CFP: 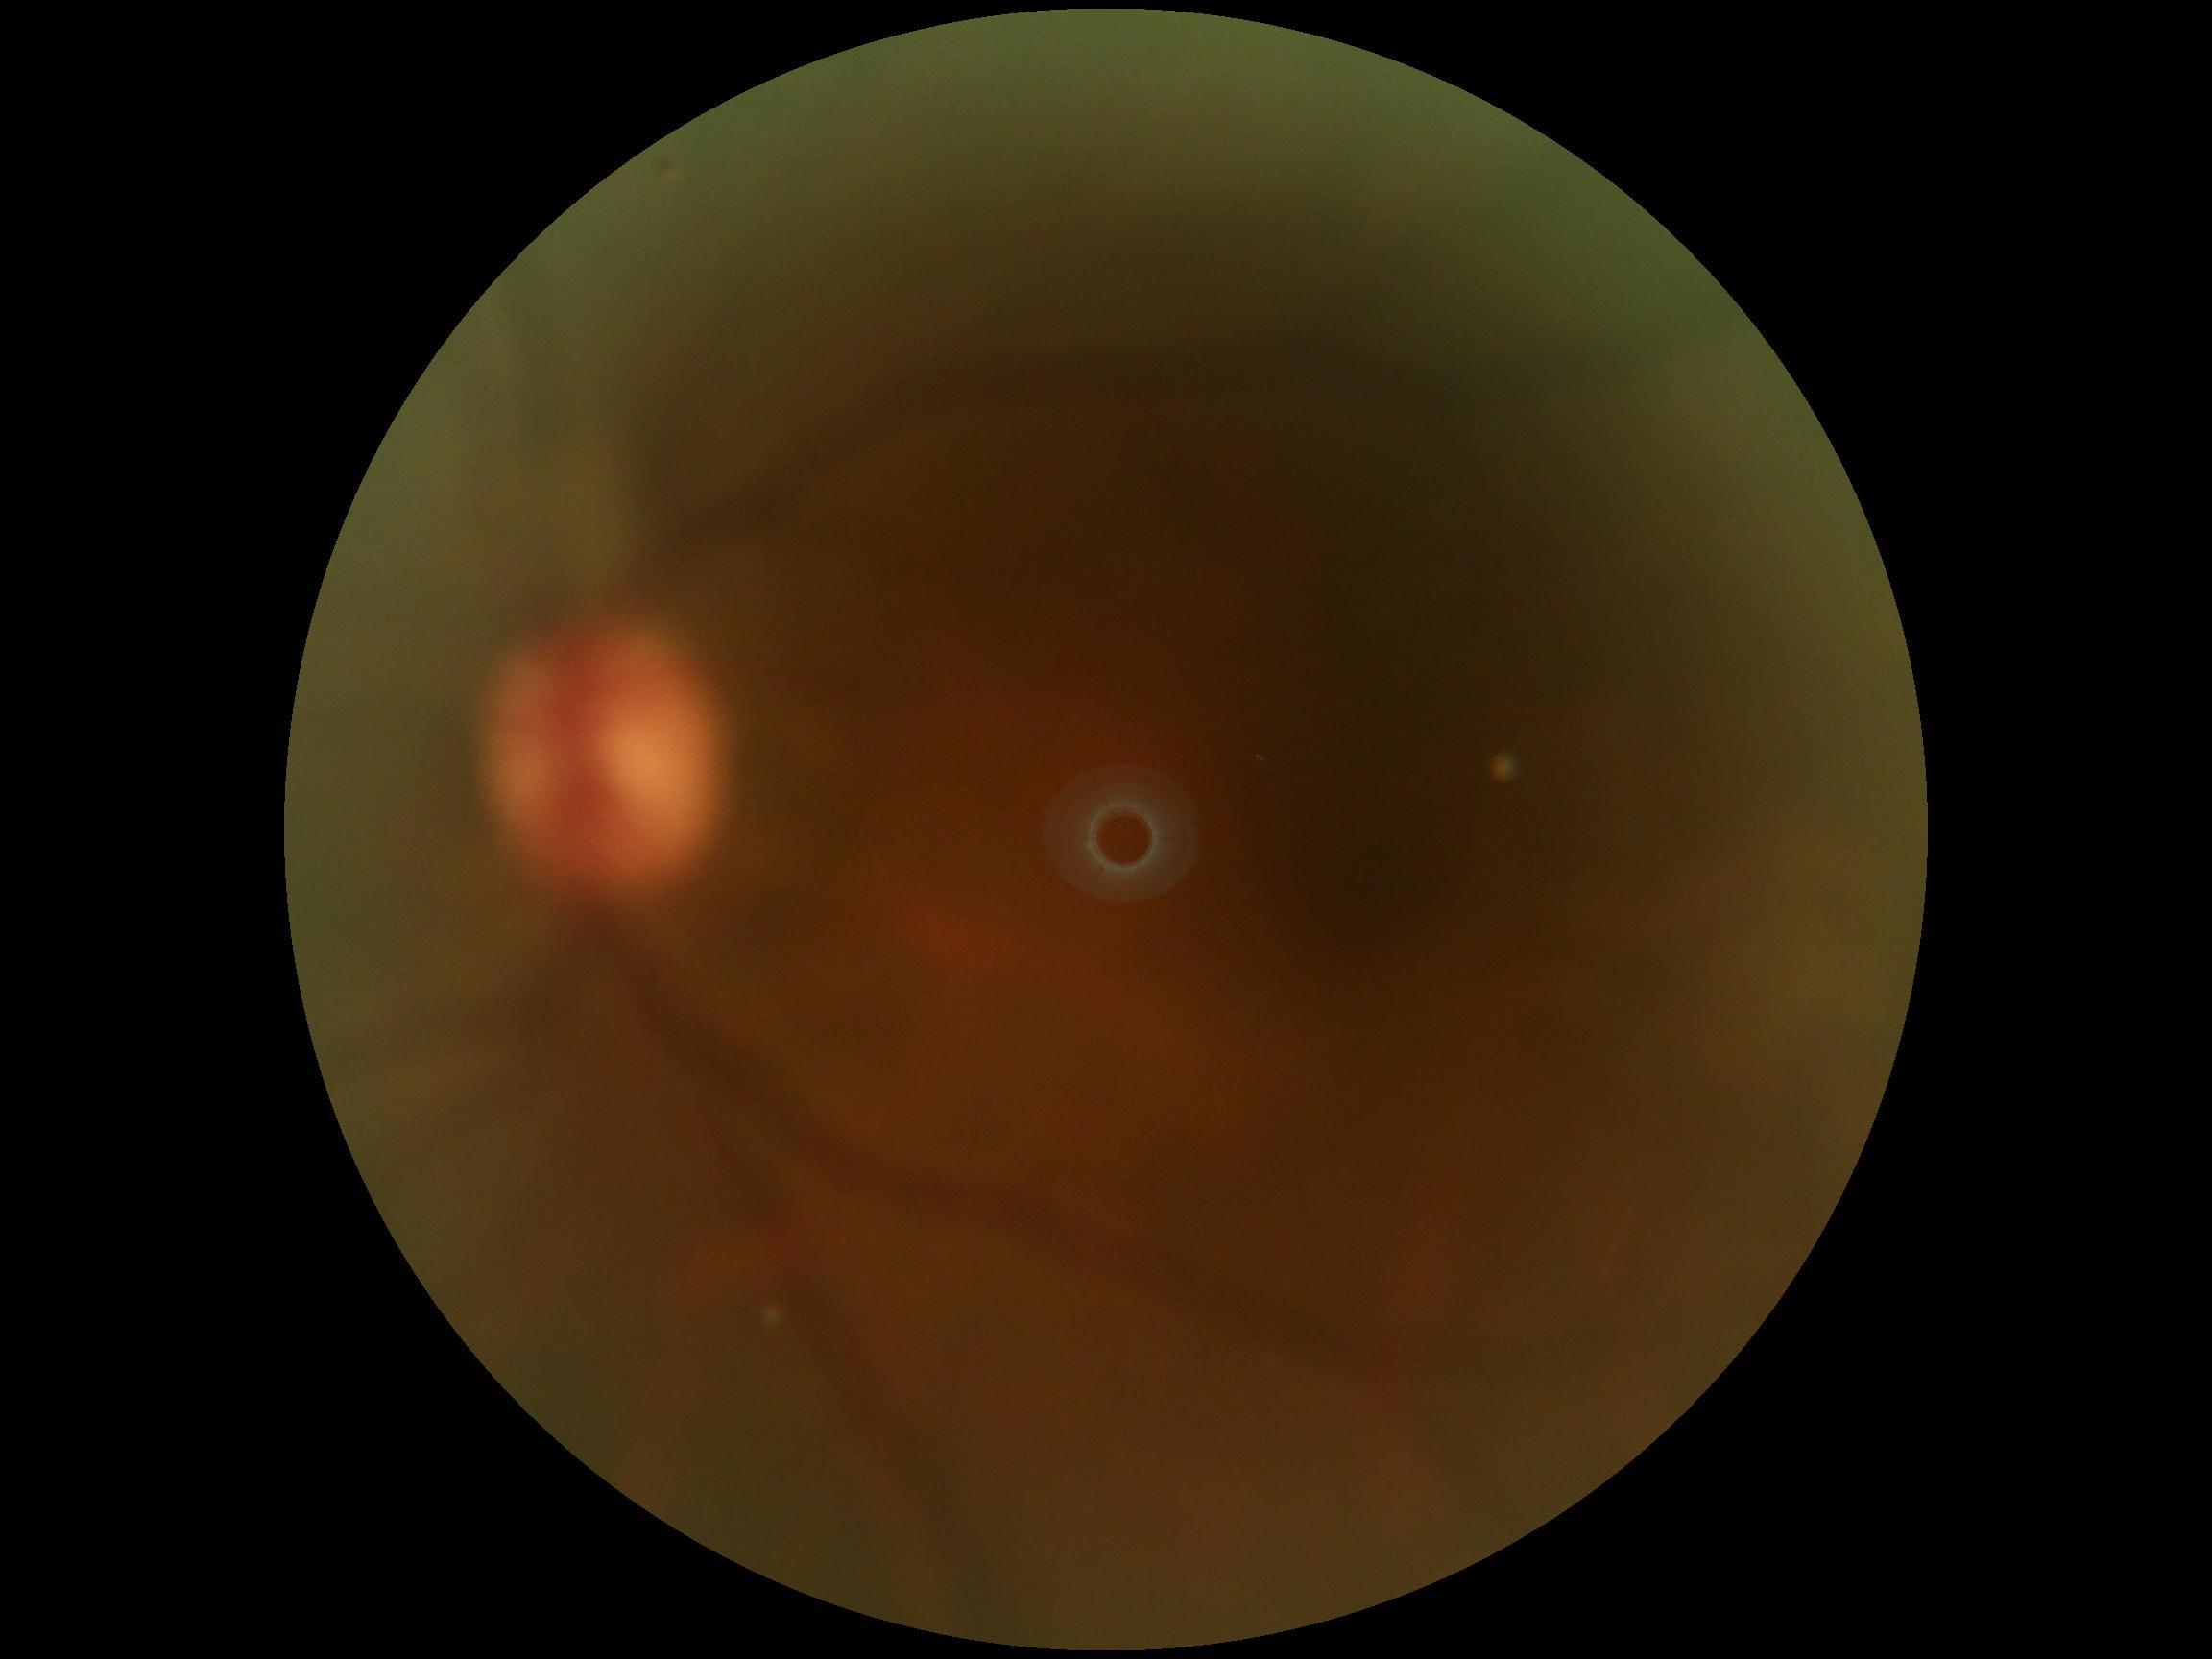
{"dr_grade": "no apparent retinopathy (grade 0)", "dr_impression": "no DR findings"}